45° field of view. Image size 1960x1897
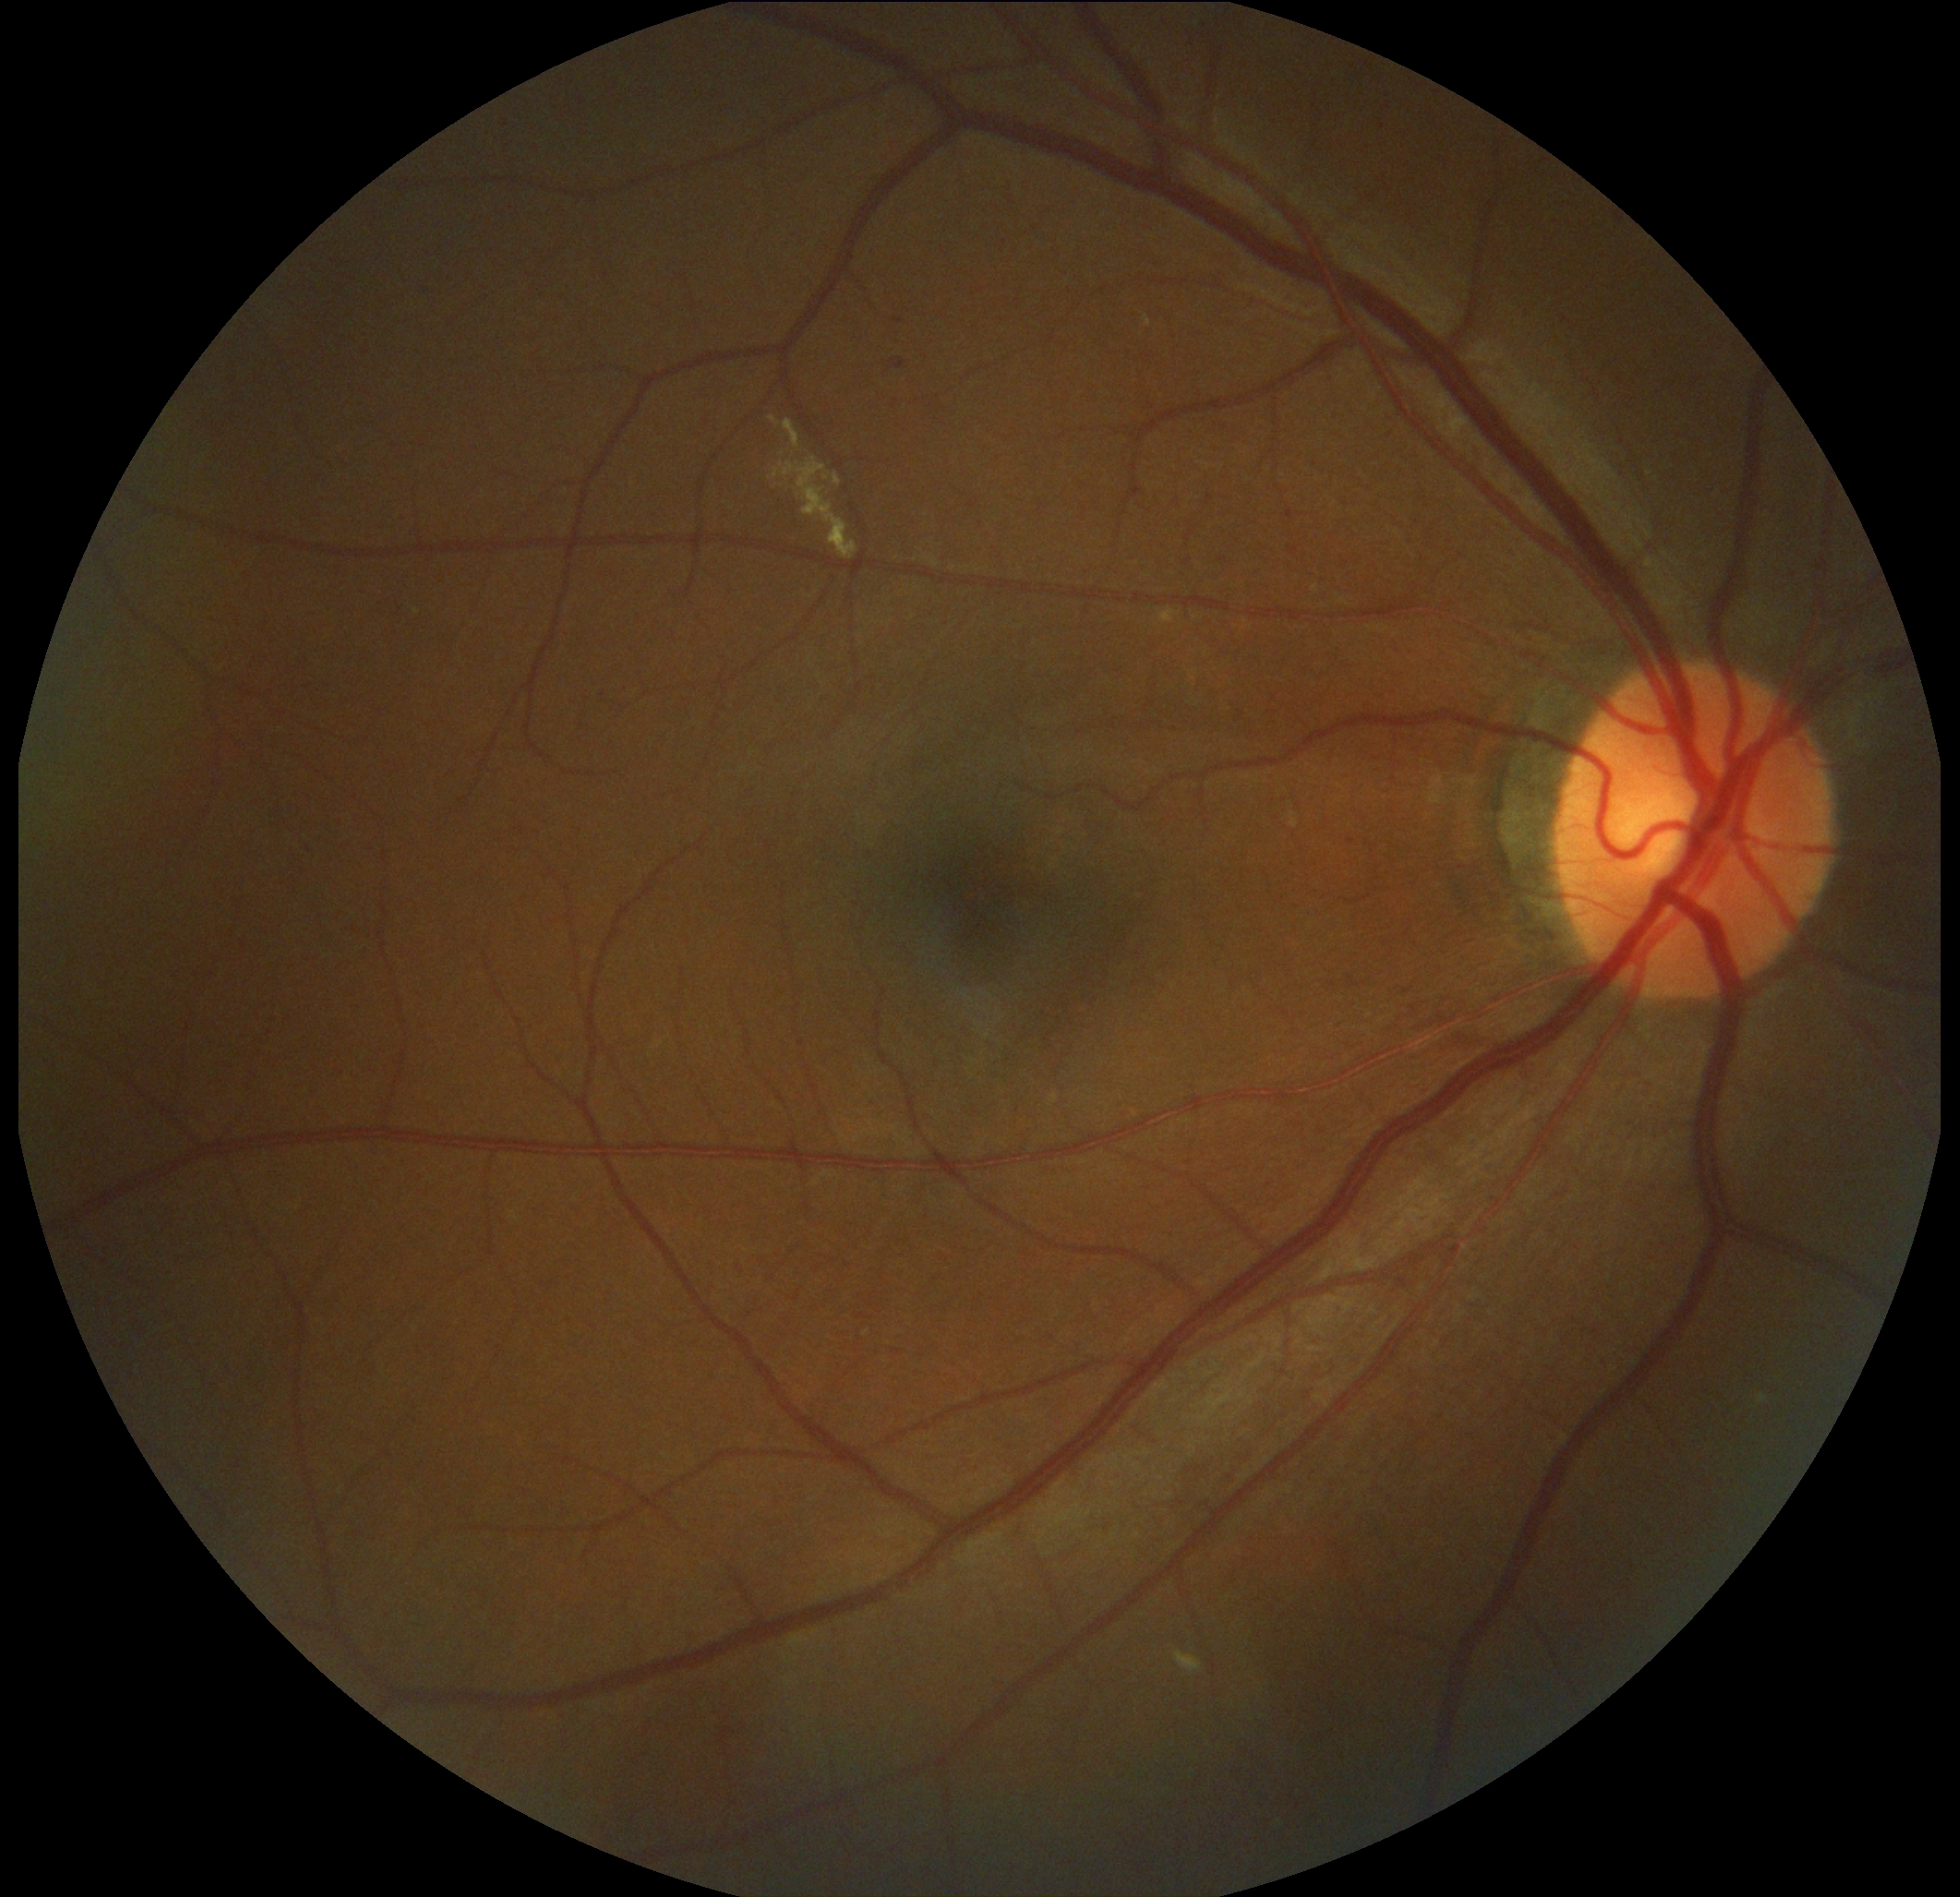 The retinopathy is classified as non-proliferative diabetic retinopathy.
DR grade: 2.